Camera: Nidek AFC-330 · 240x240.
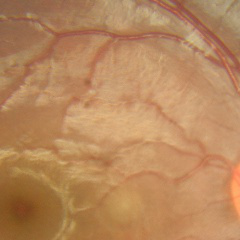

Q: What is the glaucoma diagnosis?
A: No glaucoma.